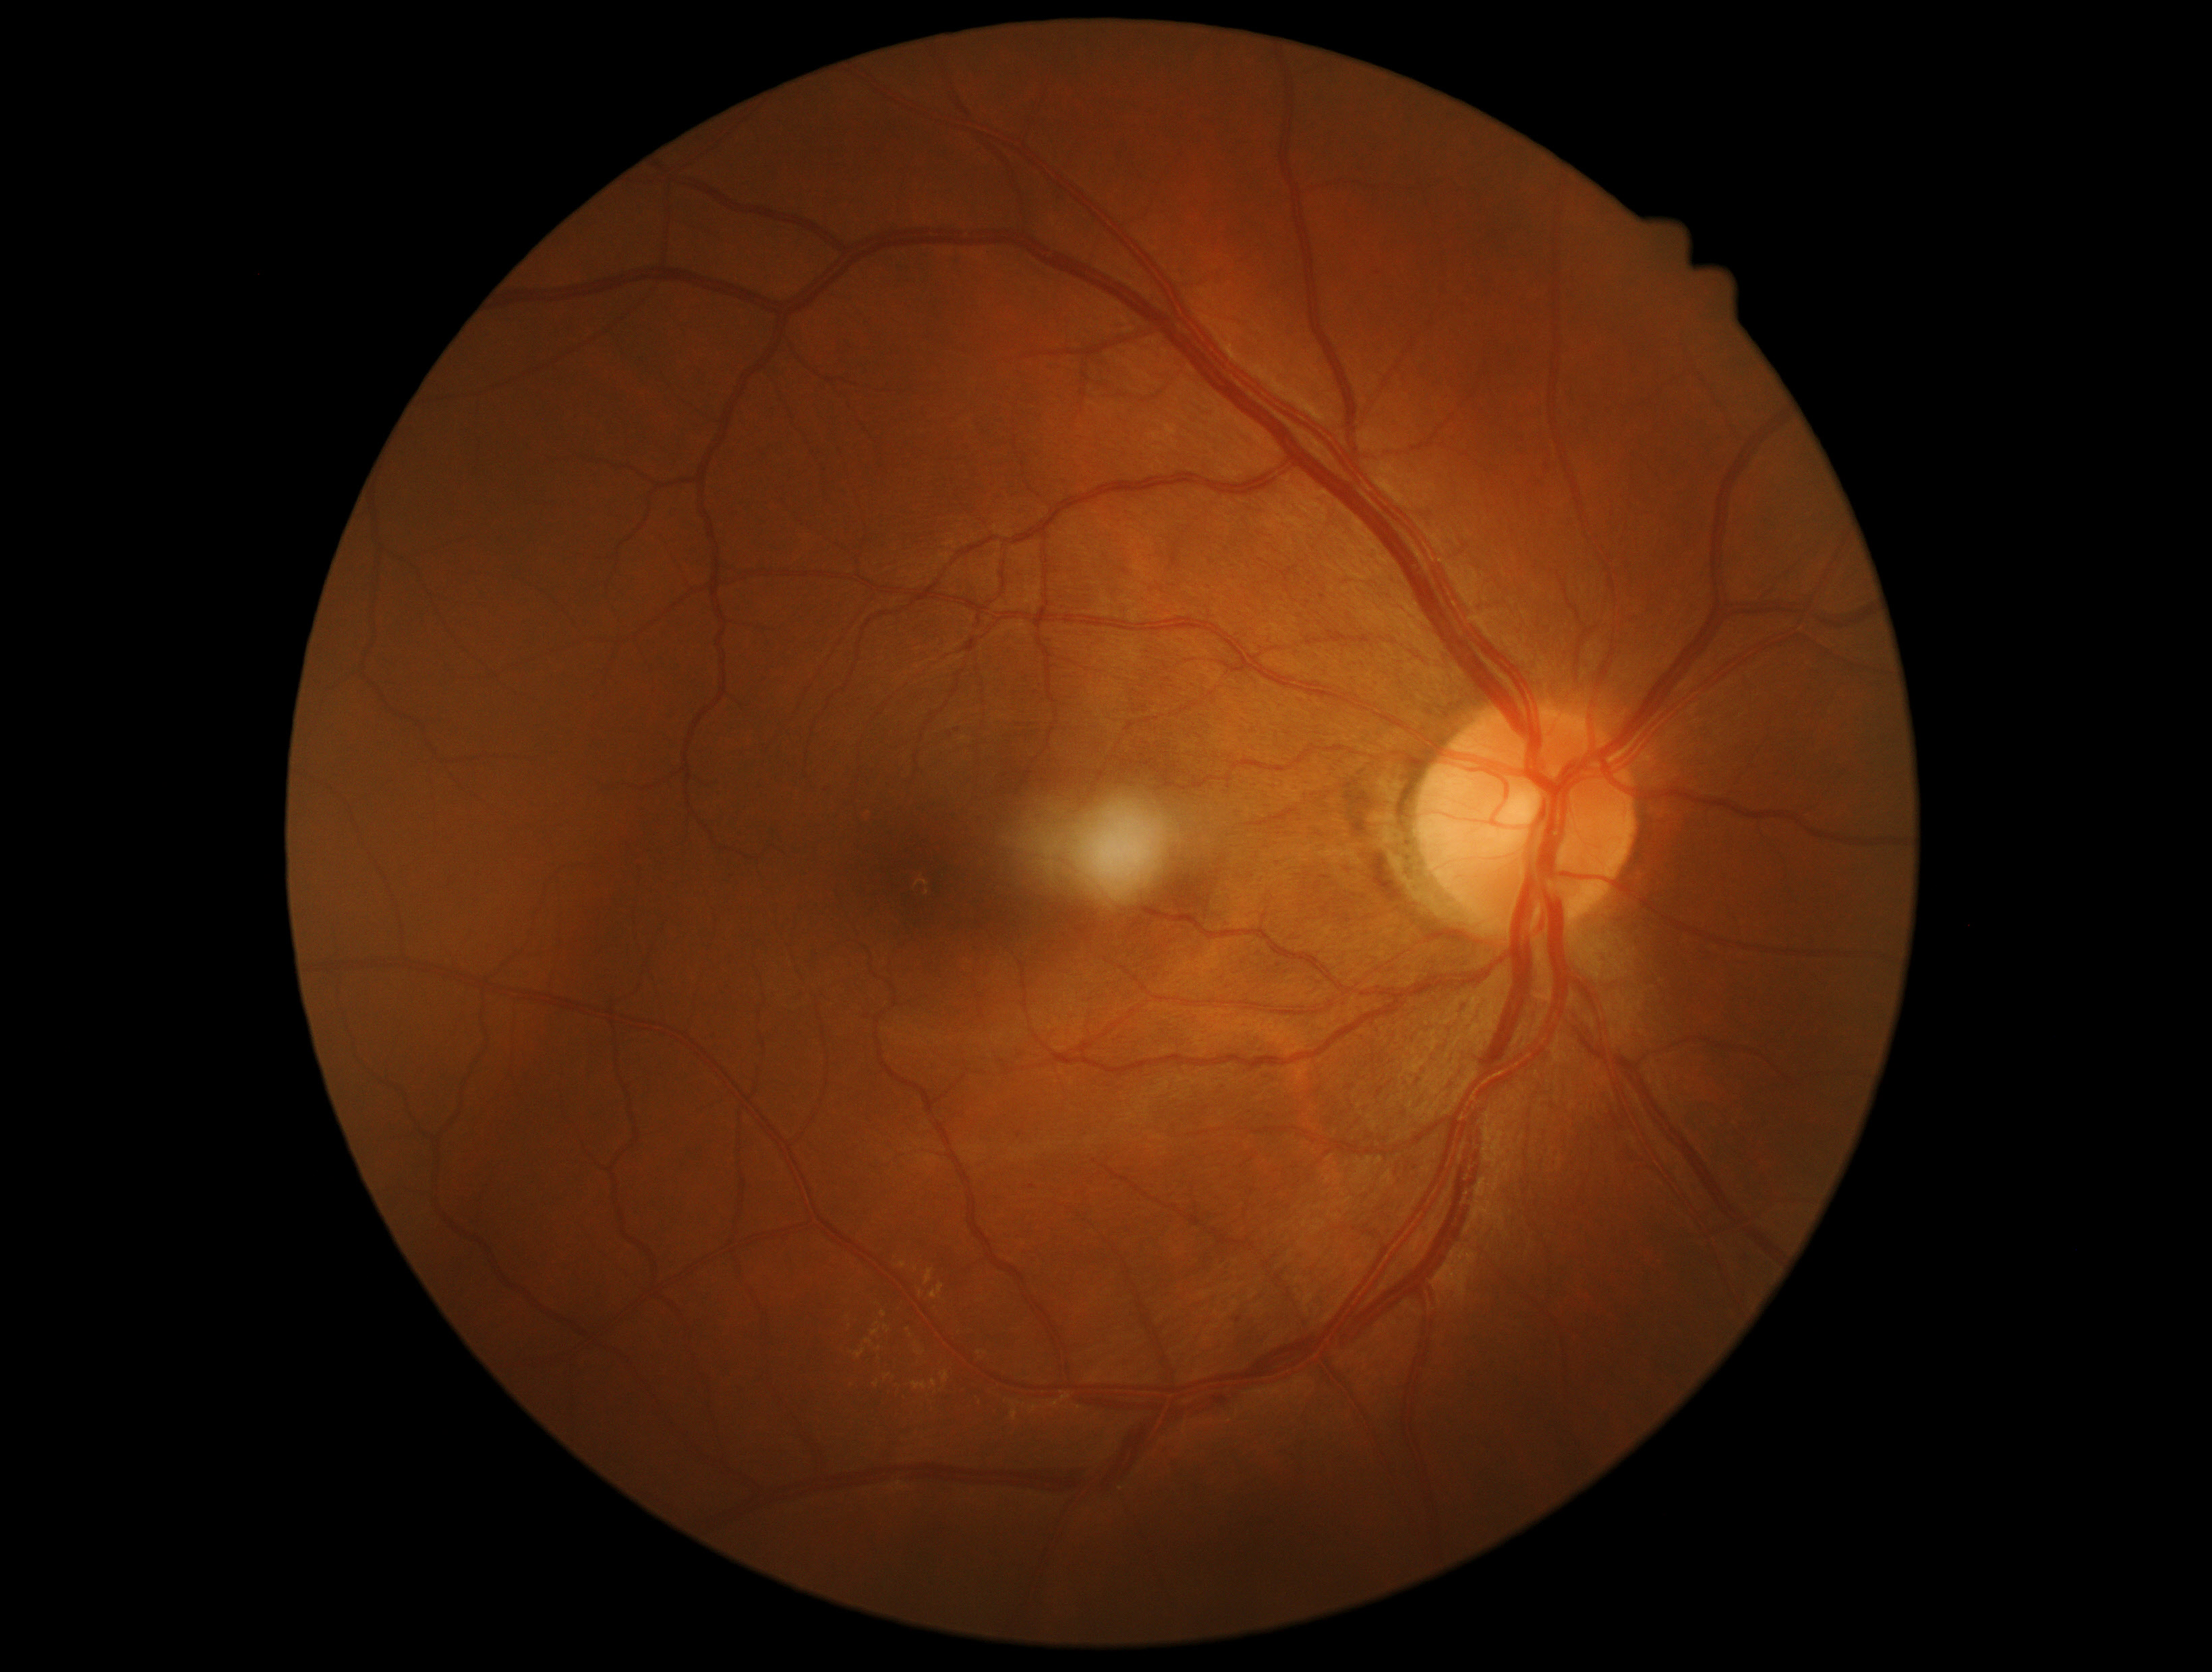 Retinopathy is grade 2.